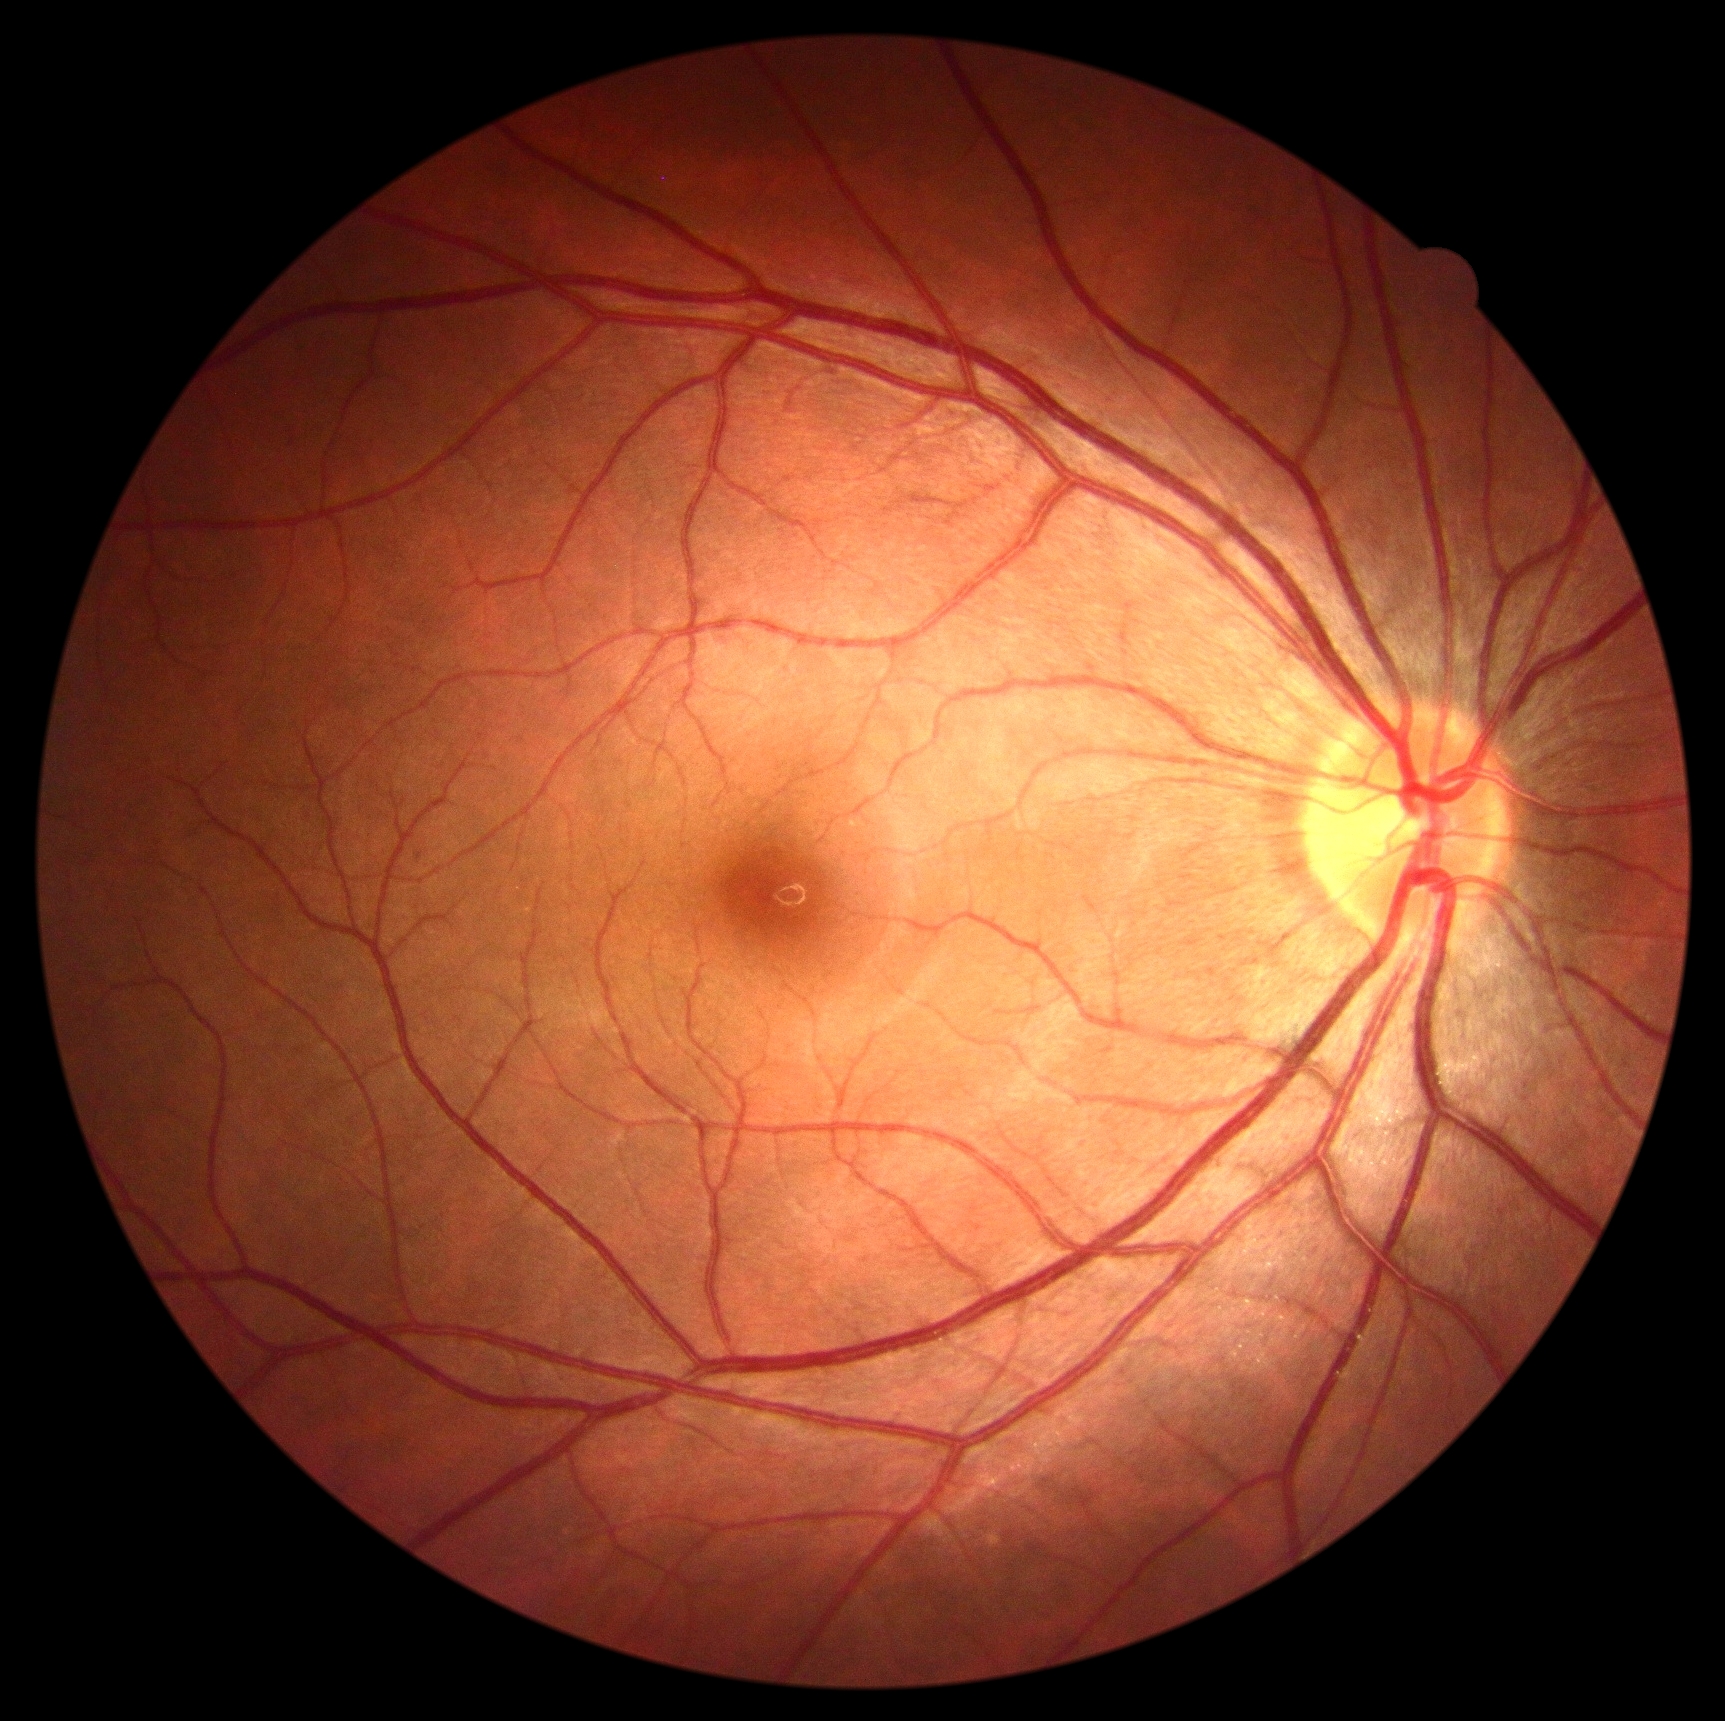 DR stage = no apparent retinopathy (grade 0).